FOV: 45 degrees: 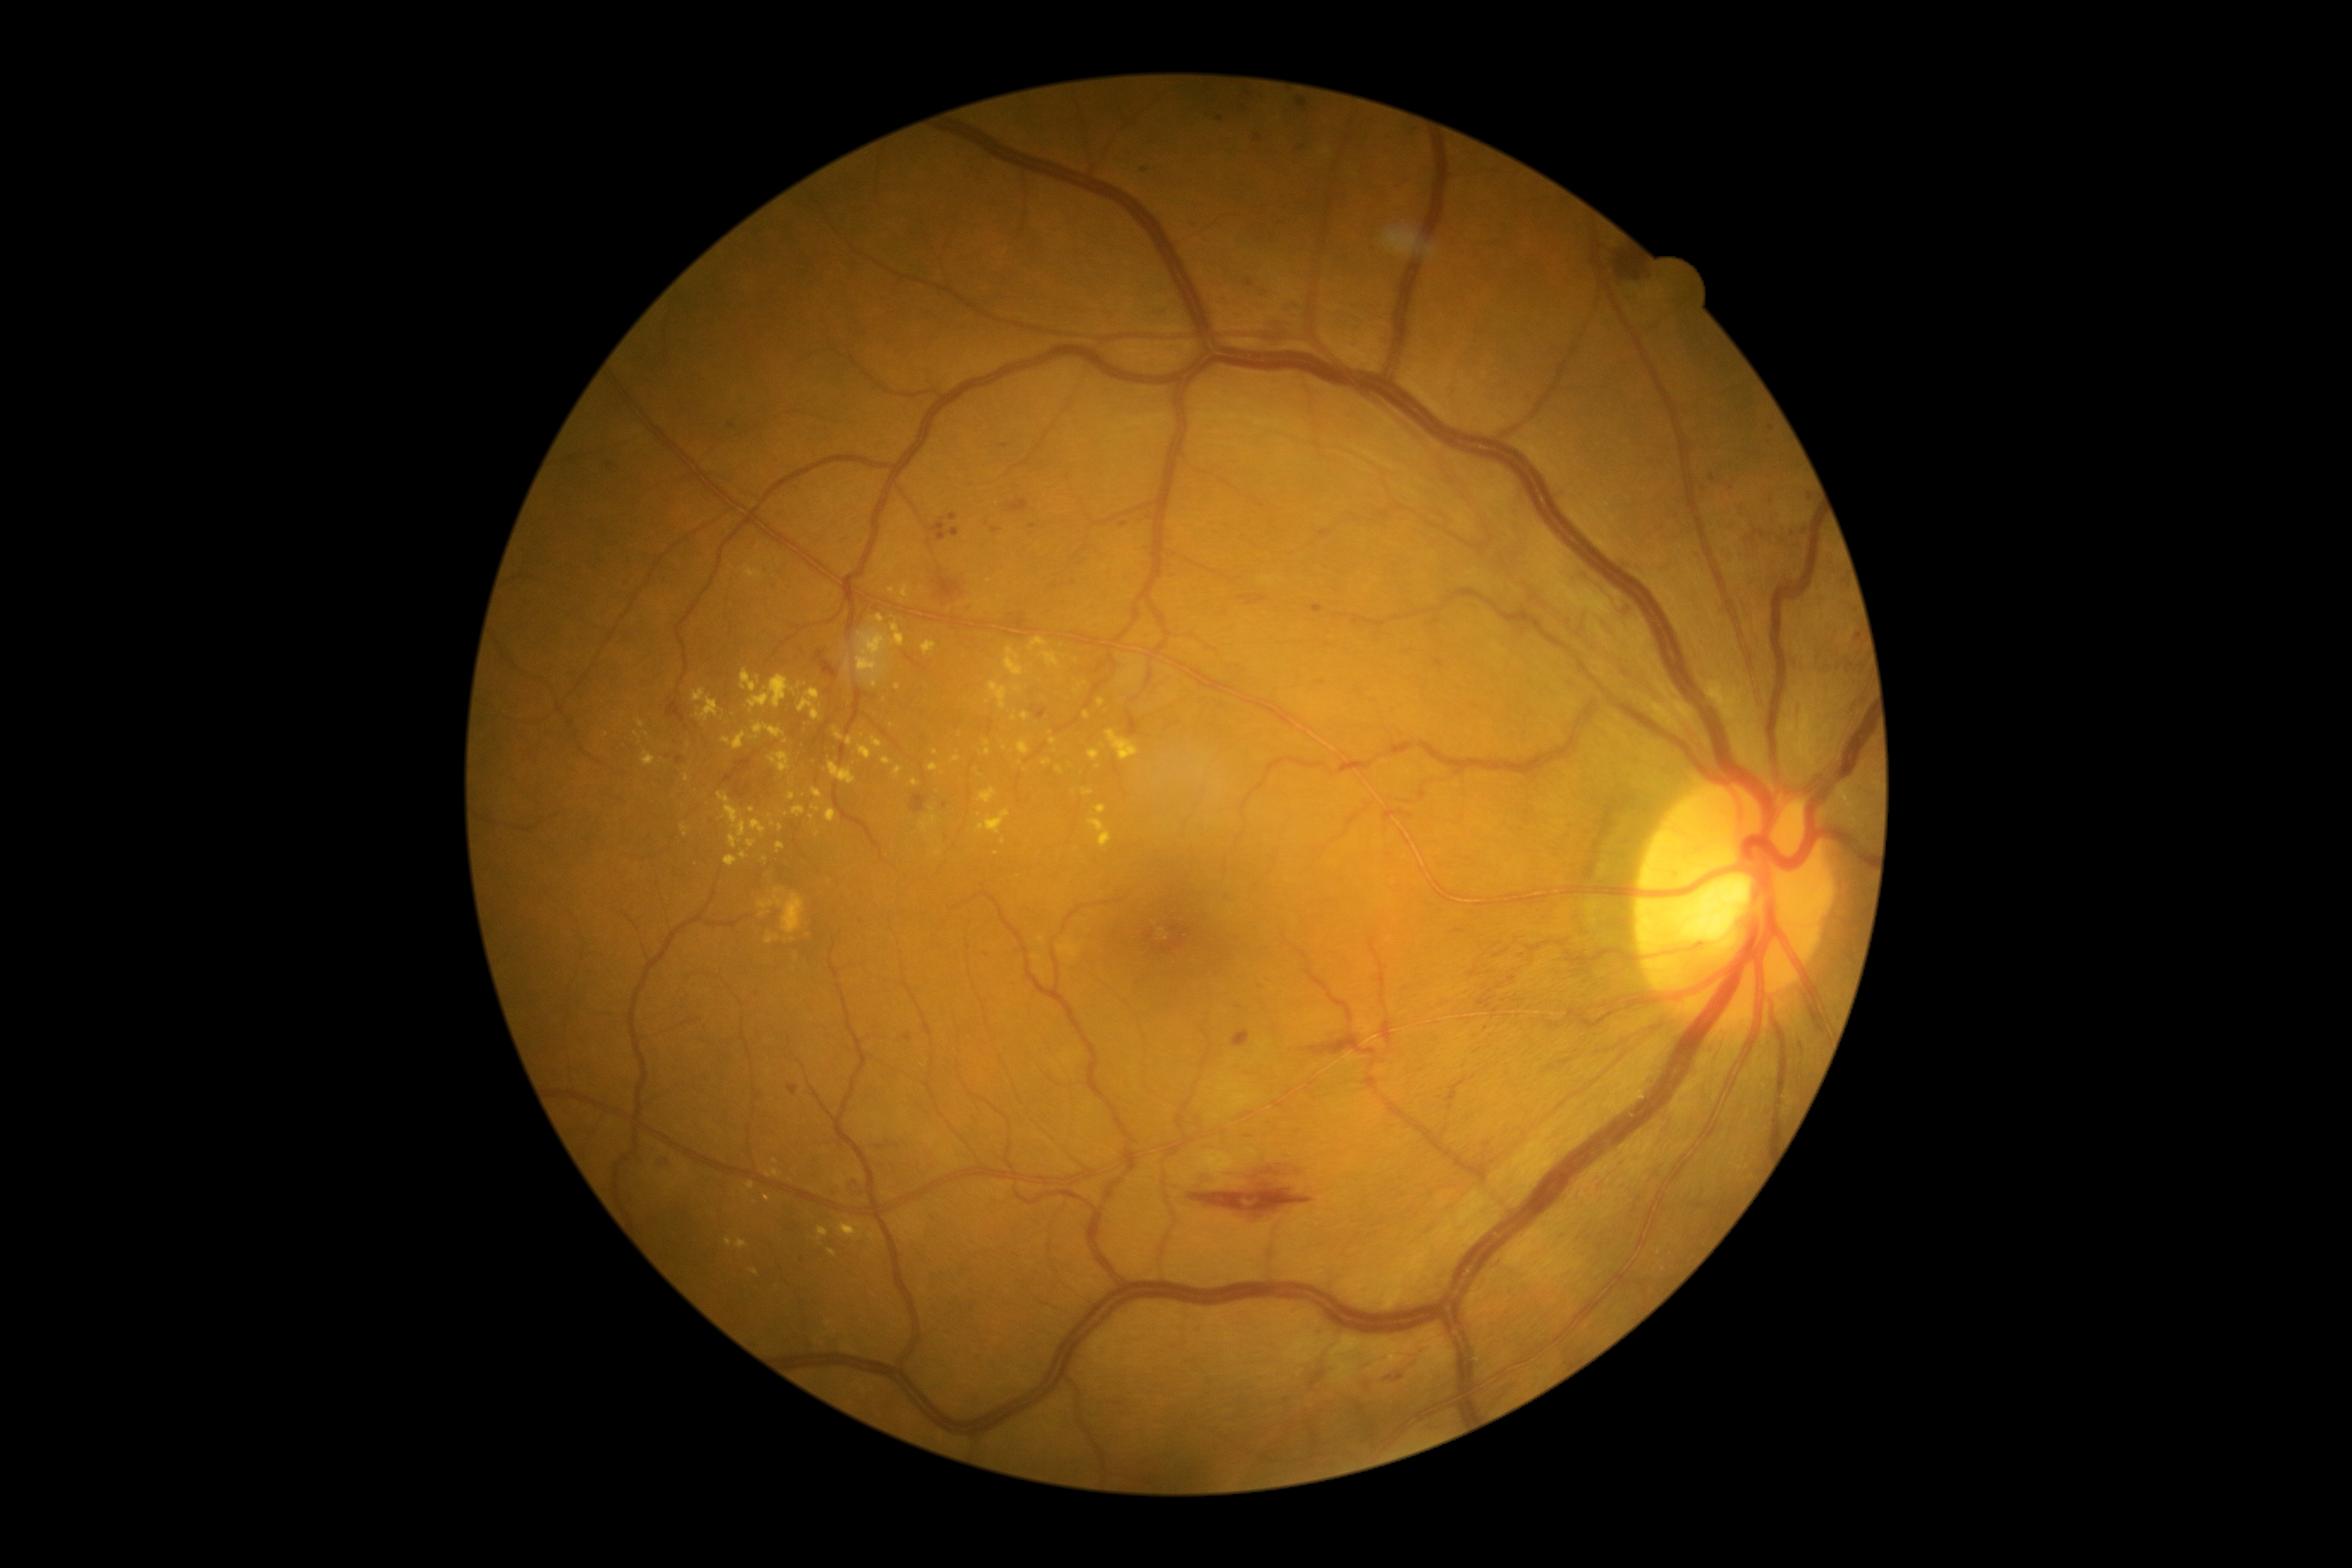
Diabetic retinopathy (DR): grade 2
Selected lesions:
microaneurysms (MAs) (more not shown): region(1748, 530, 1767, 542) | region(1316, 680, 1326, 687) | region(948, 513, 959, 522) | region(926, 518, 960, 541) | region(1509, 976, 1517, 983) | region(903, 1034, 912, 1043) | region(1516, 998, 1524, 1003) | region(1311, 604, 1325, 615) | region(728, 424, 737, 431) | region(788, 1084, 799, 1096)
Small MAs approximately at (1714, 478) | (1033, 527) | (930, 544) | (1302, 148) | (610, 465) | (1266, 293) | (1145, 171) | (1850, 666) | (1805, 531)
hard exudates (EXs) (more not shown): region(1084, 711, 1091, 720) | region(921, 821, 928, 833) | region(812, 805, 821, 812) | region(883, 560, 898, 570) | region(857, 622, 905, 687) | region(881, 757, 893, 766) | region(1041, 651, 1060, 668) | region(922, 640, 938, 654) | region(847, 737, 854, 747) | region(977, 811, 1010, 835) | region(1096, 804, 1108, 814) | region(769, 752, 792, 775)
Small EXs approximately at (863, 735) | (996, 853) | (1130, 537) | (637, 735) | (768, 1177) | (987, 752) | (898, 687) | (606, 735)
hemorrhages (HEs): region(1005, 499, 1029, 513) | region(721, 752, 778, 805) | region(1301, 1032, 1378, 1057) | region(668, 702, 685, 725) | region(848, 1179, 864, 1194) | region(1031, 707, 1048, 720) | region(1614, 252, 1646, 283) | region(1239, 596, 1270, 606) | region(1234, 1031, 1251, 1048) | region(934, 568, 964, 601) | region(654, 1160, 666, 1170) | region(812, 651, 840, 680) | region(675, 756, 683, 764) | region(910, 795, 929, 812) | region(1189, 1182, 1314, 1218) | region(1127, 711, 1141, 737) | region(1010, 615, 1026, 628) | region(1249, 319, 1285, 346) | region(1363, 1357, 1421, 1395)
soft exudates (SEs): none identified